ONH-centered crop from a color fundus image.
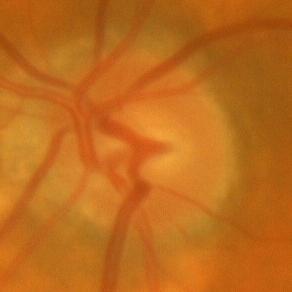

No signs of glaucoma.